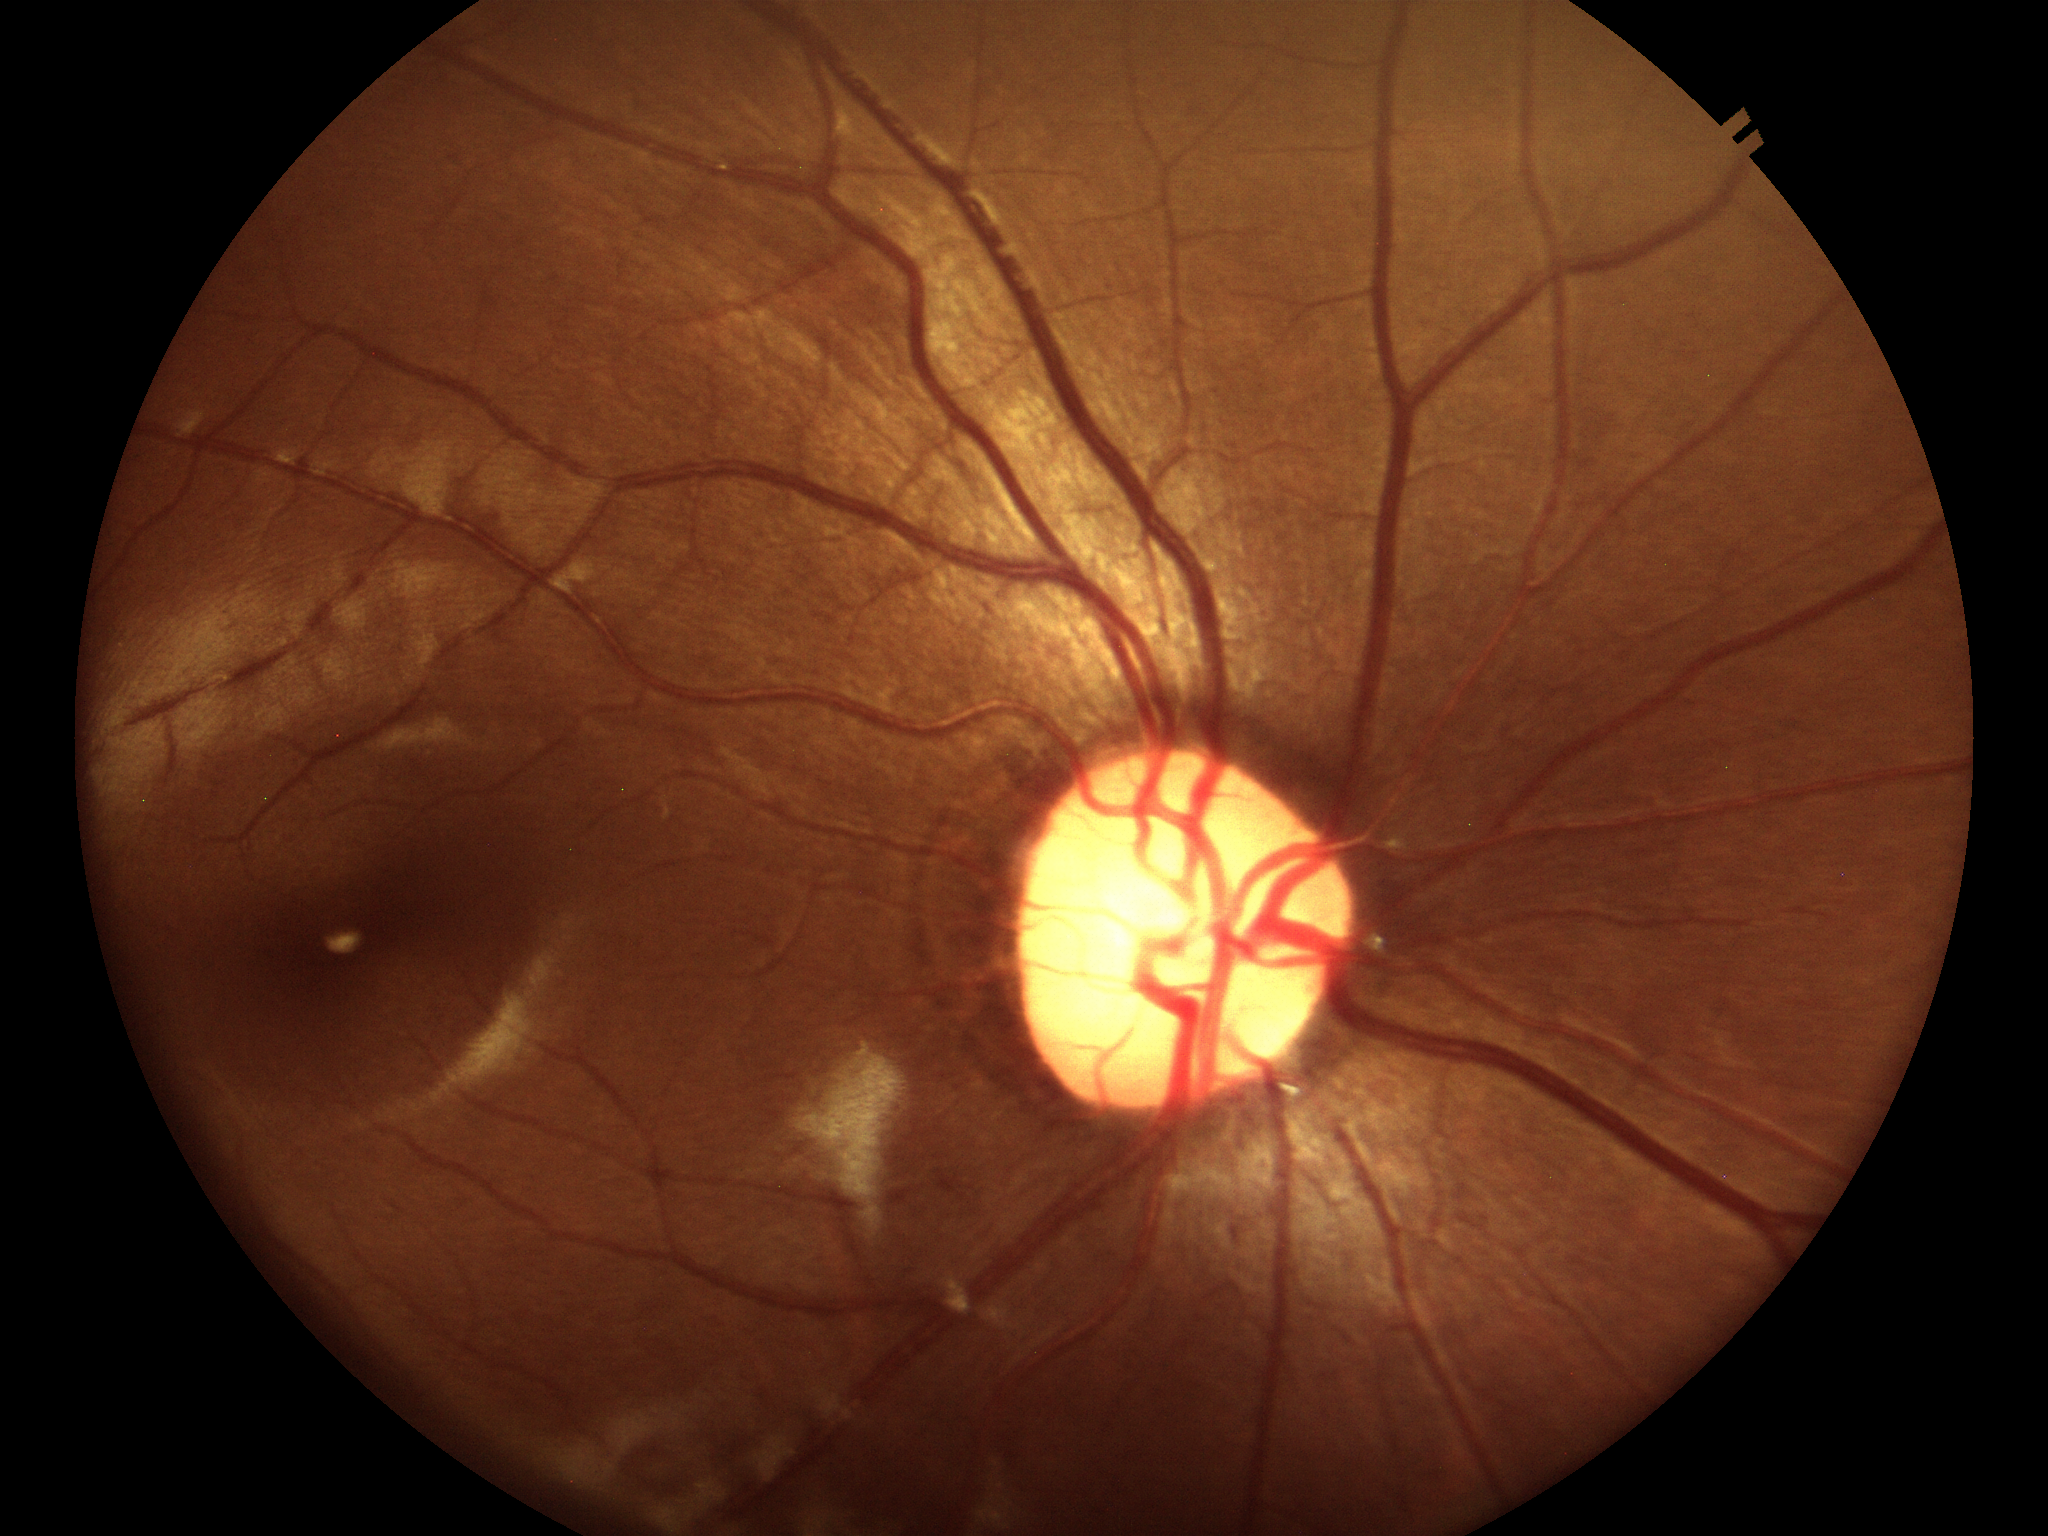
Q: Is there glaucoma suspicion?
A: negative
Q: What is the vertical cup-to-disc ratio?
A: 0.61
Q: What is the horizontal cup-to-disc ratio?
A: 0.54